CFP: 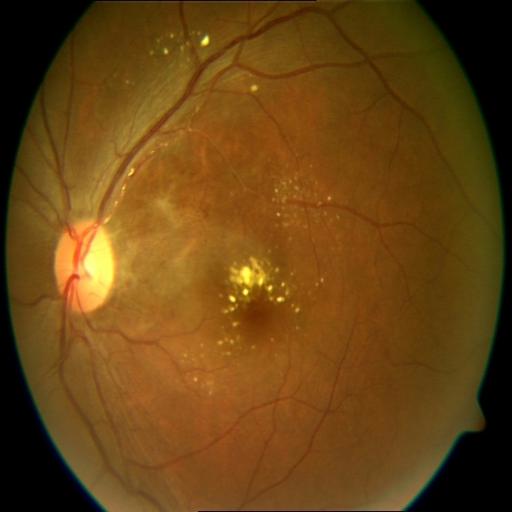
Findings: CME (cystoid macular edema), EDN (exudation).